1924 x 1556 pixels.
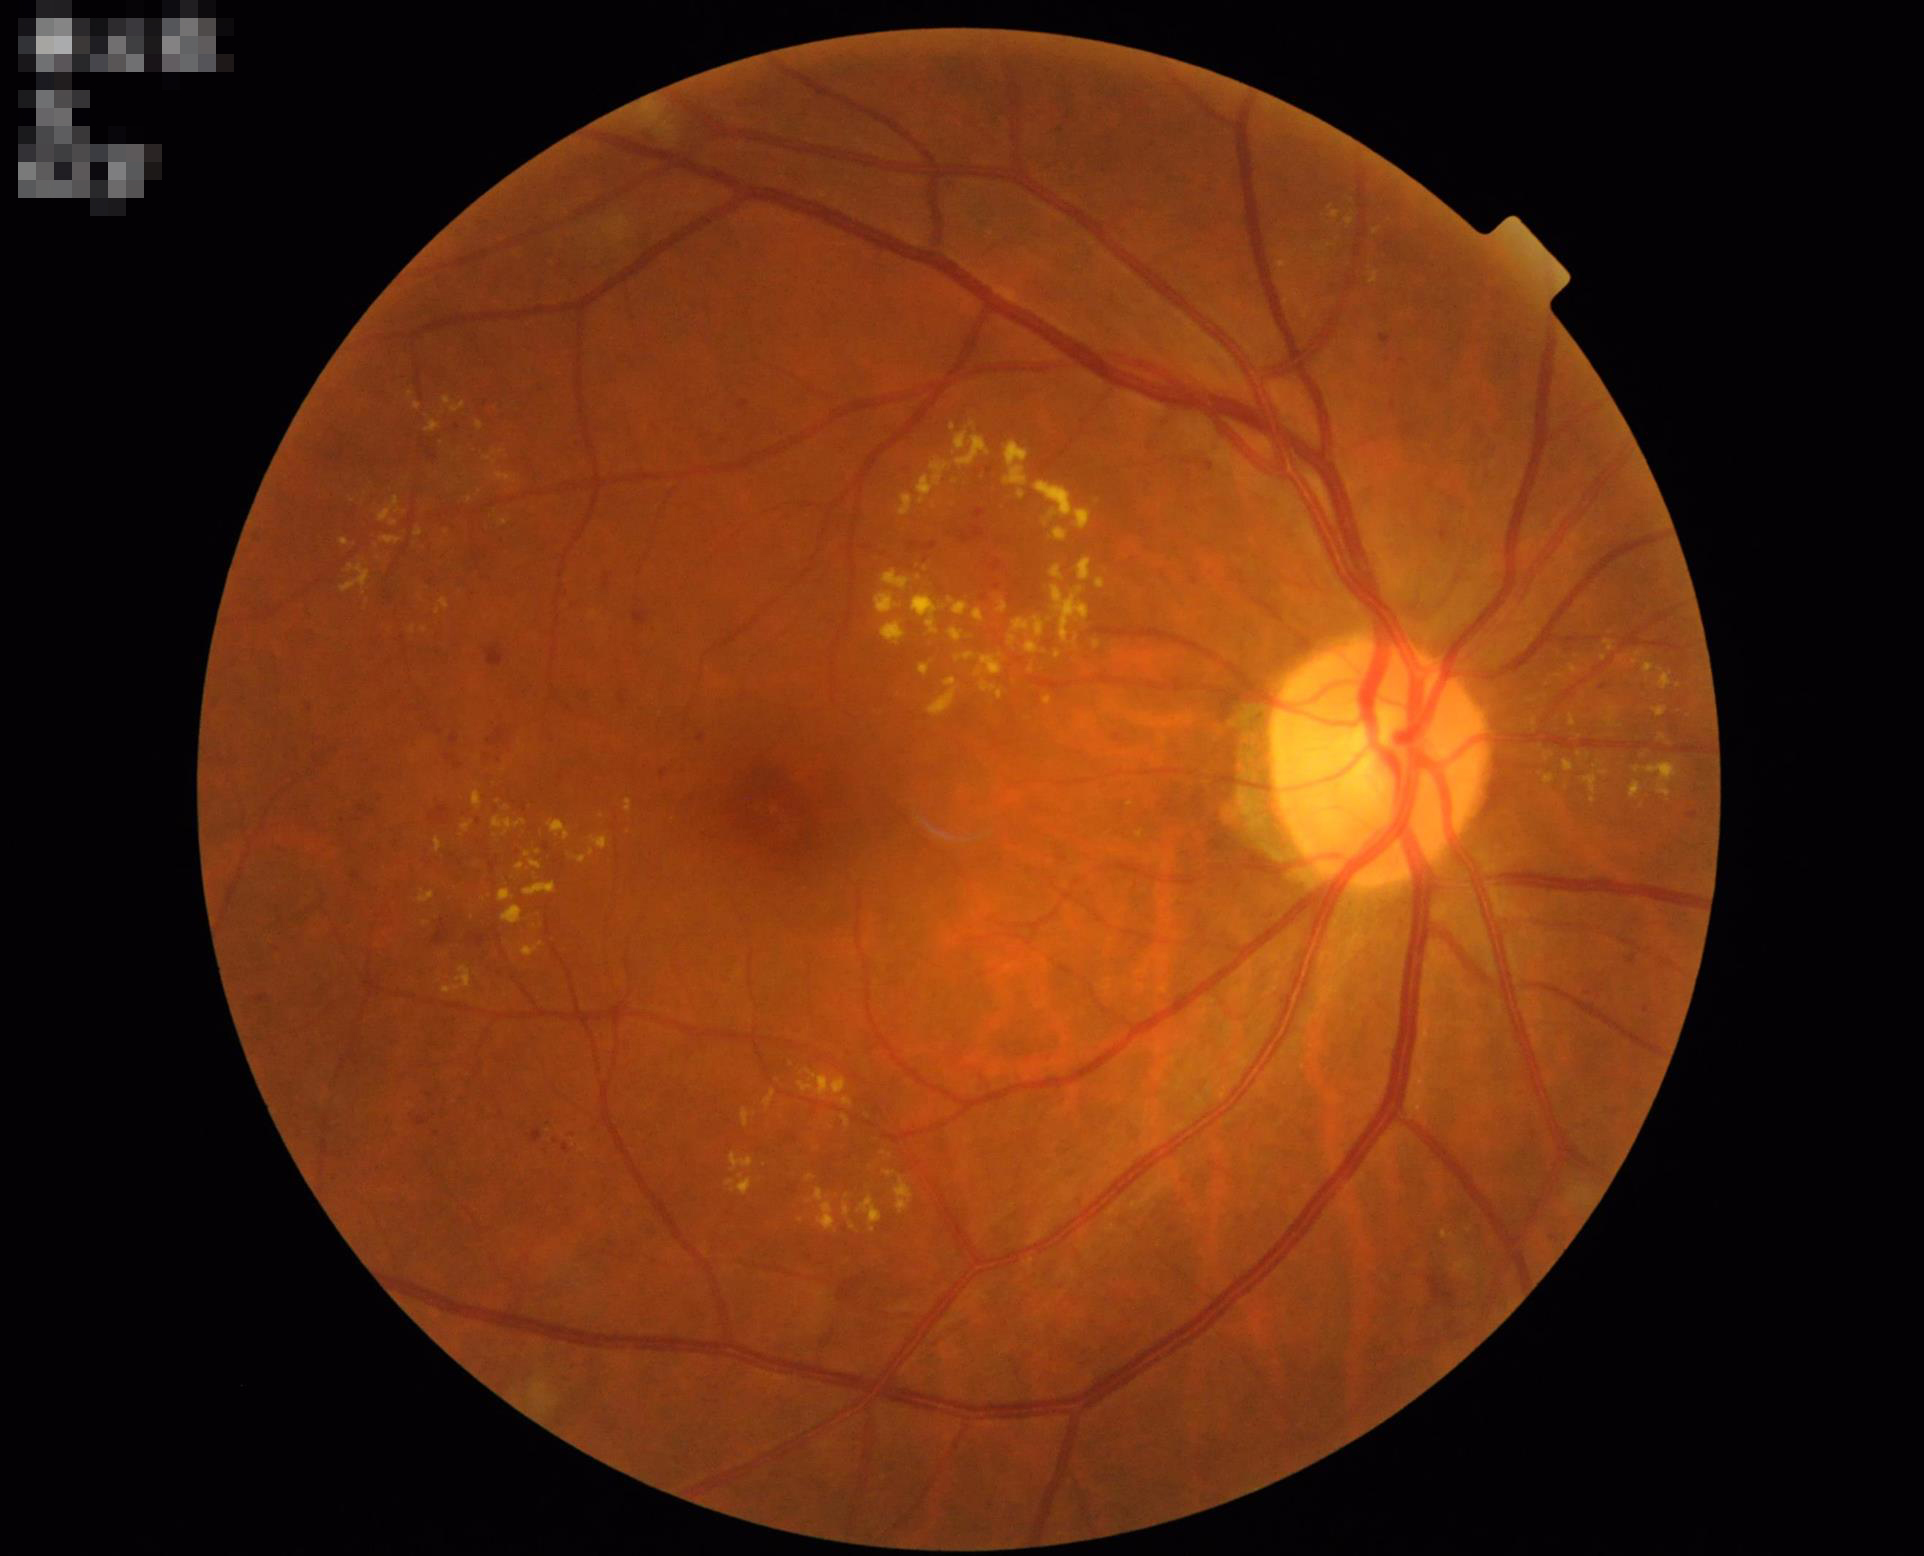
Quality grading: illumination/color: even | sharpness: clear | overall: good.